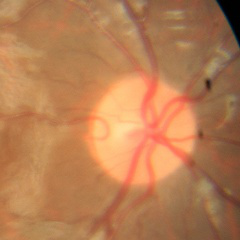

Showing no evidence of glaucoma.